Nonmydriatic fundus photograph. Modified Davis classification. NIDEK AFC-230 fundus camera.
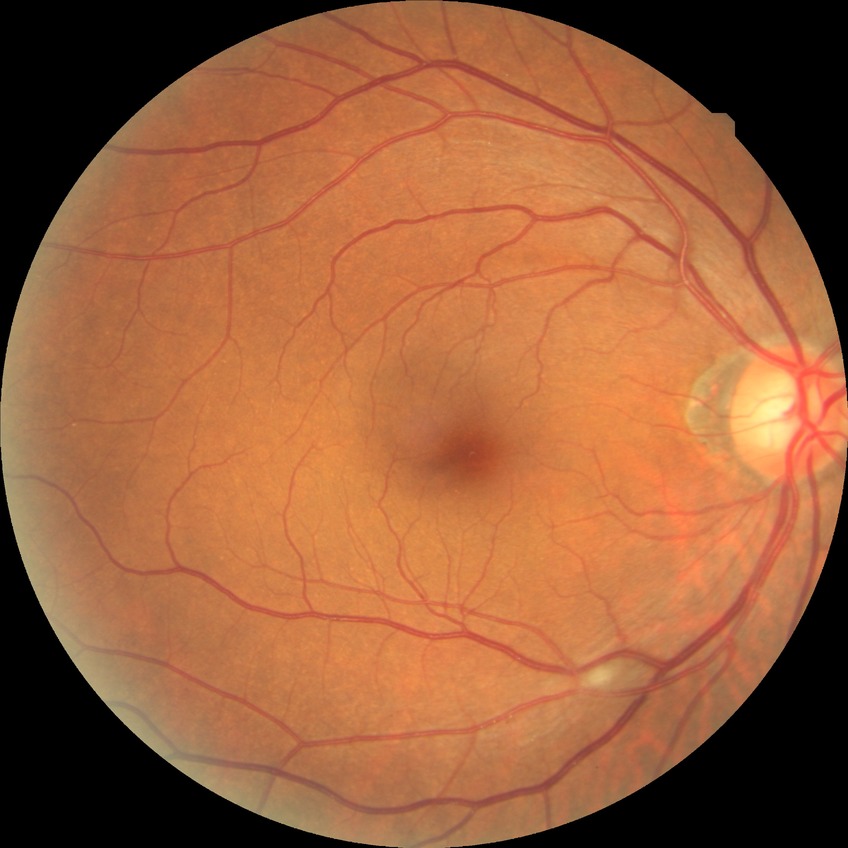
Retinopathy grade: no diabetic retinopathy.